Camera: NIDEK AFC-230
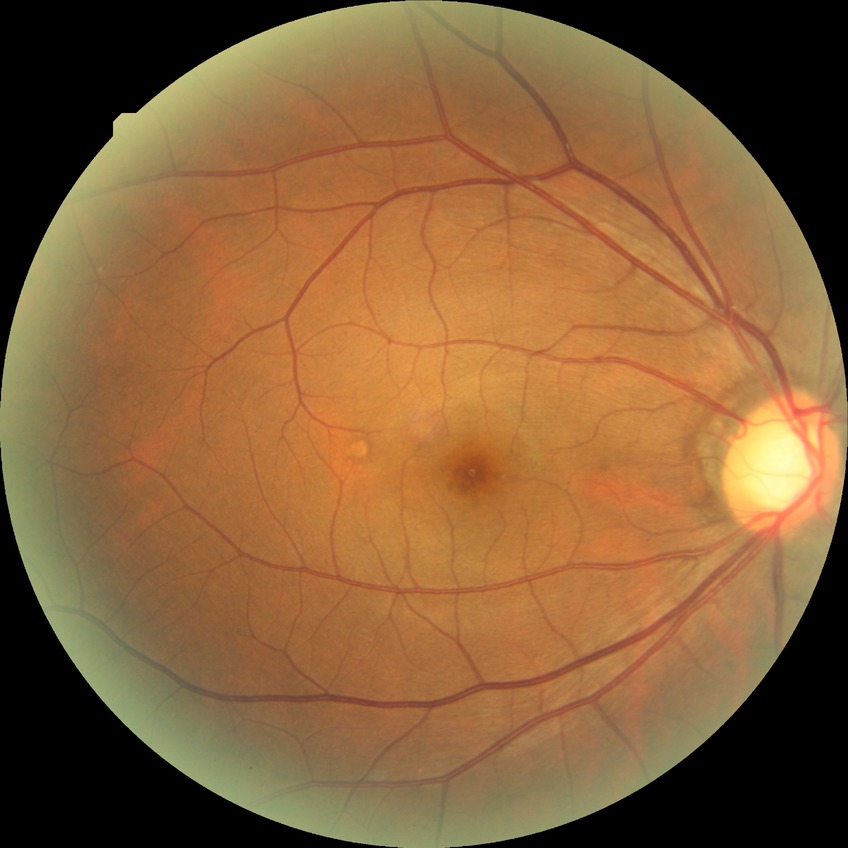

– modified Davis classification — no diabetic retinopathy